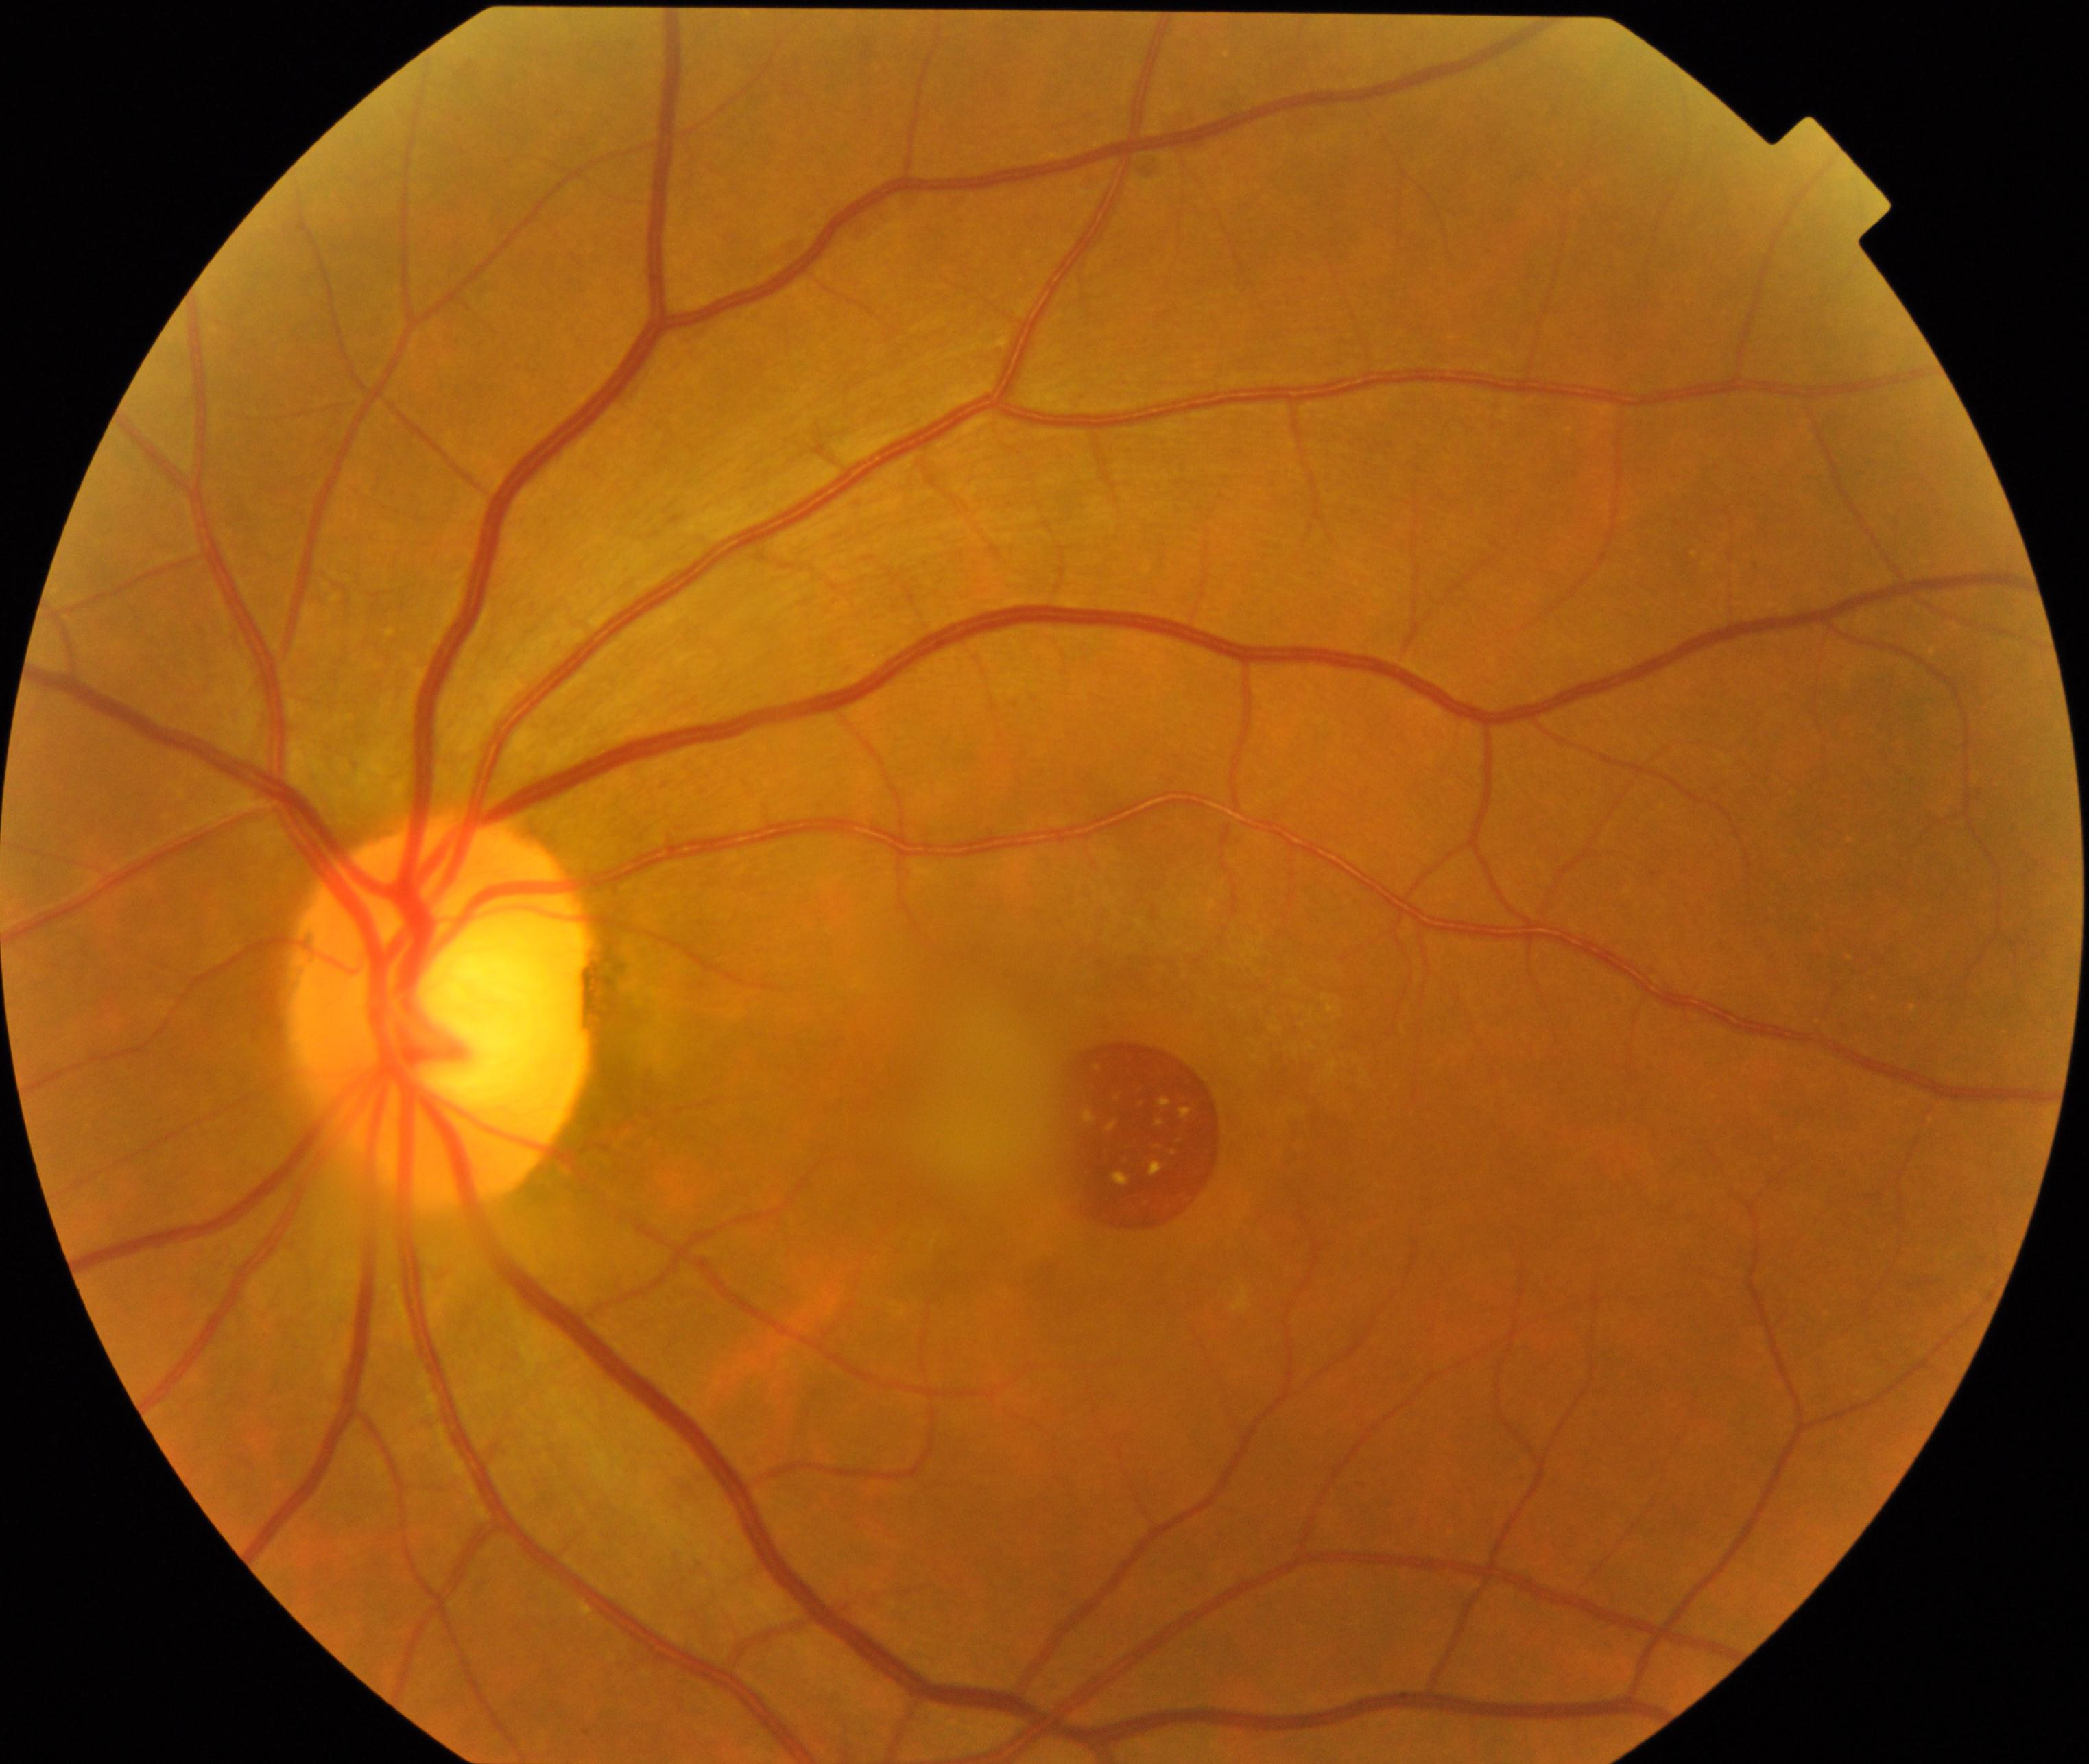

There is evidence of MH (macular hole).